45-degree field of view.
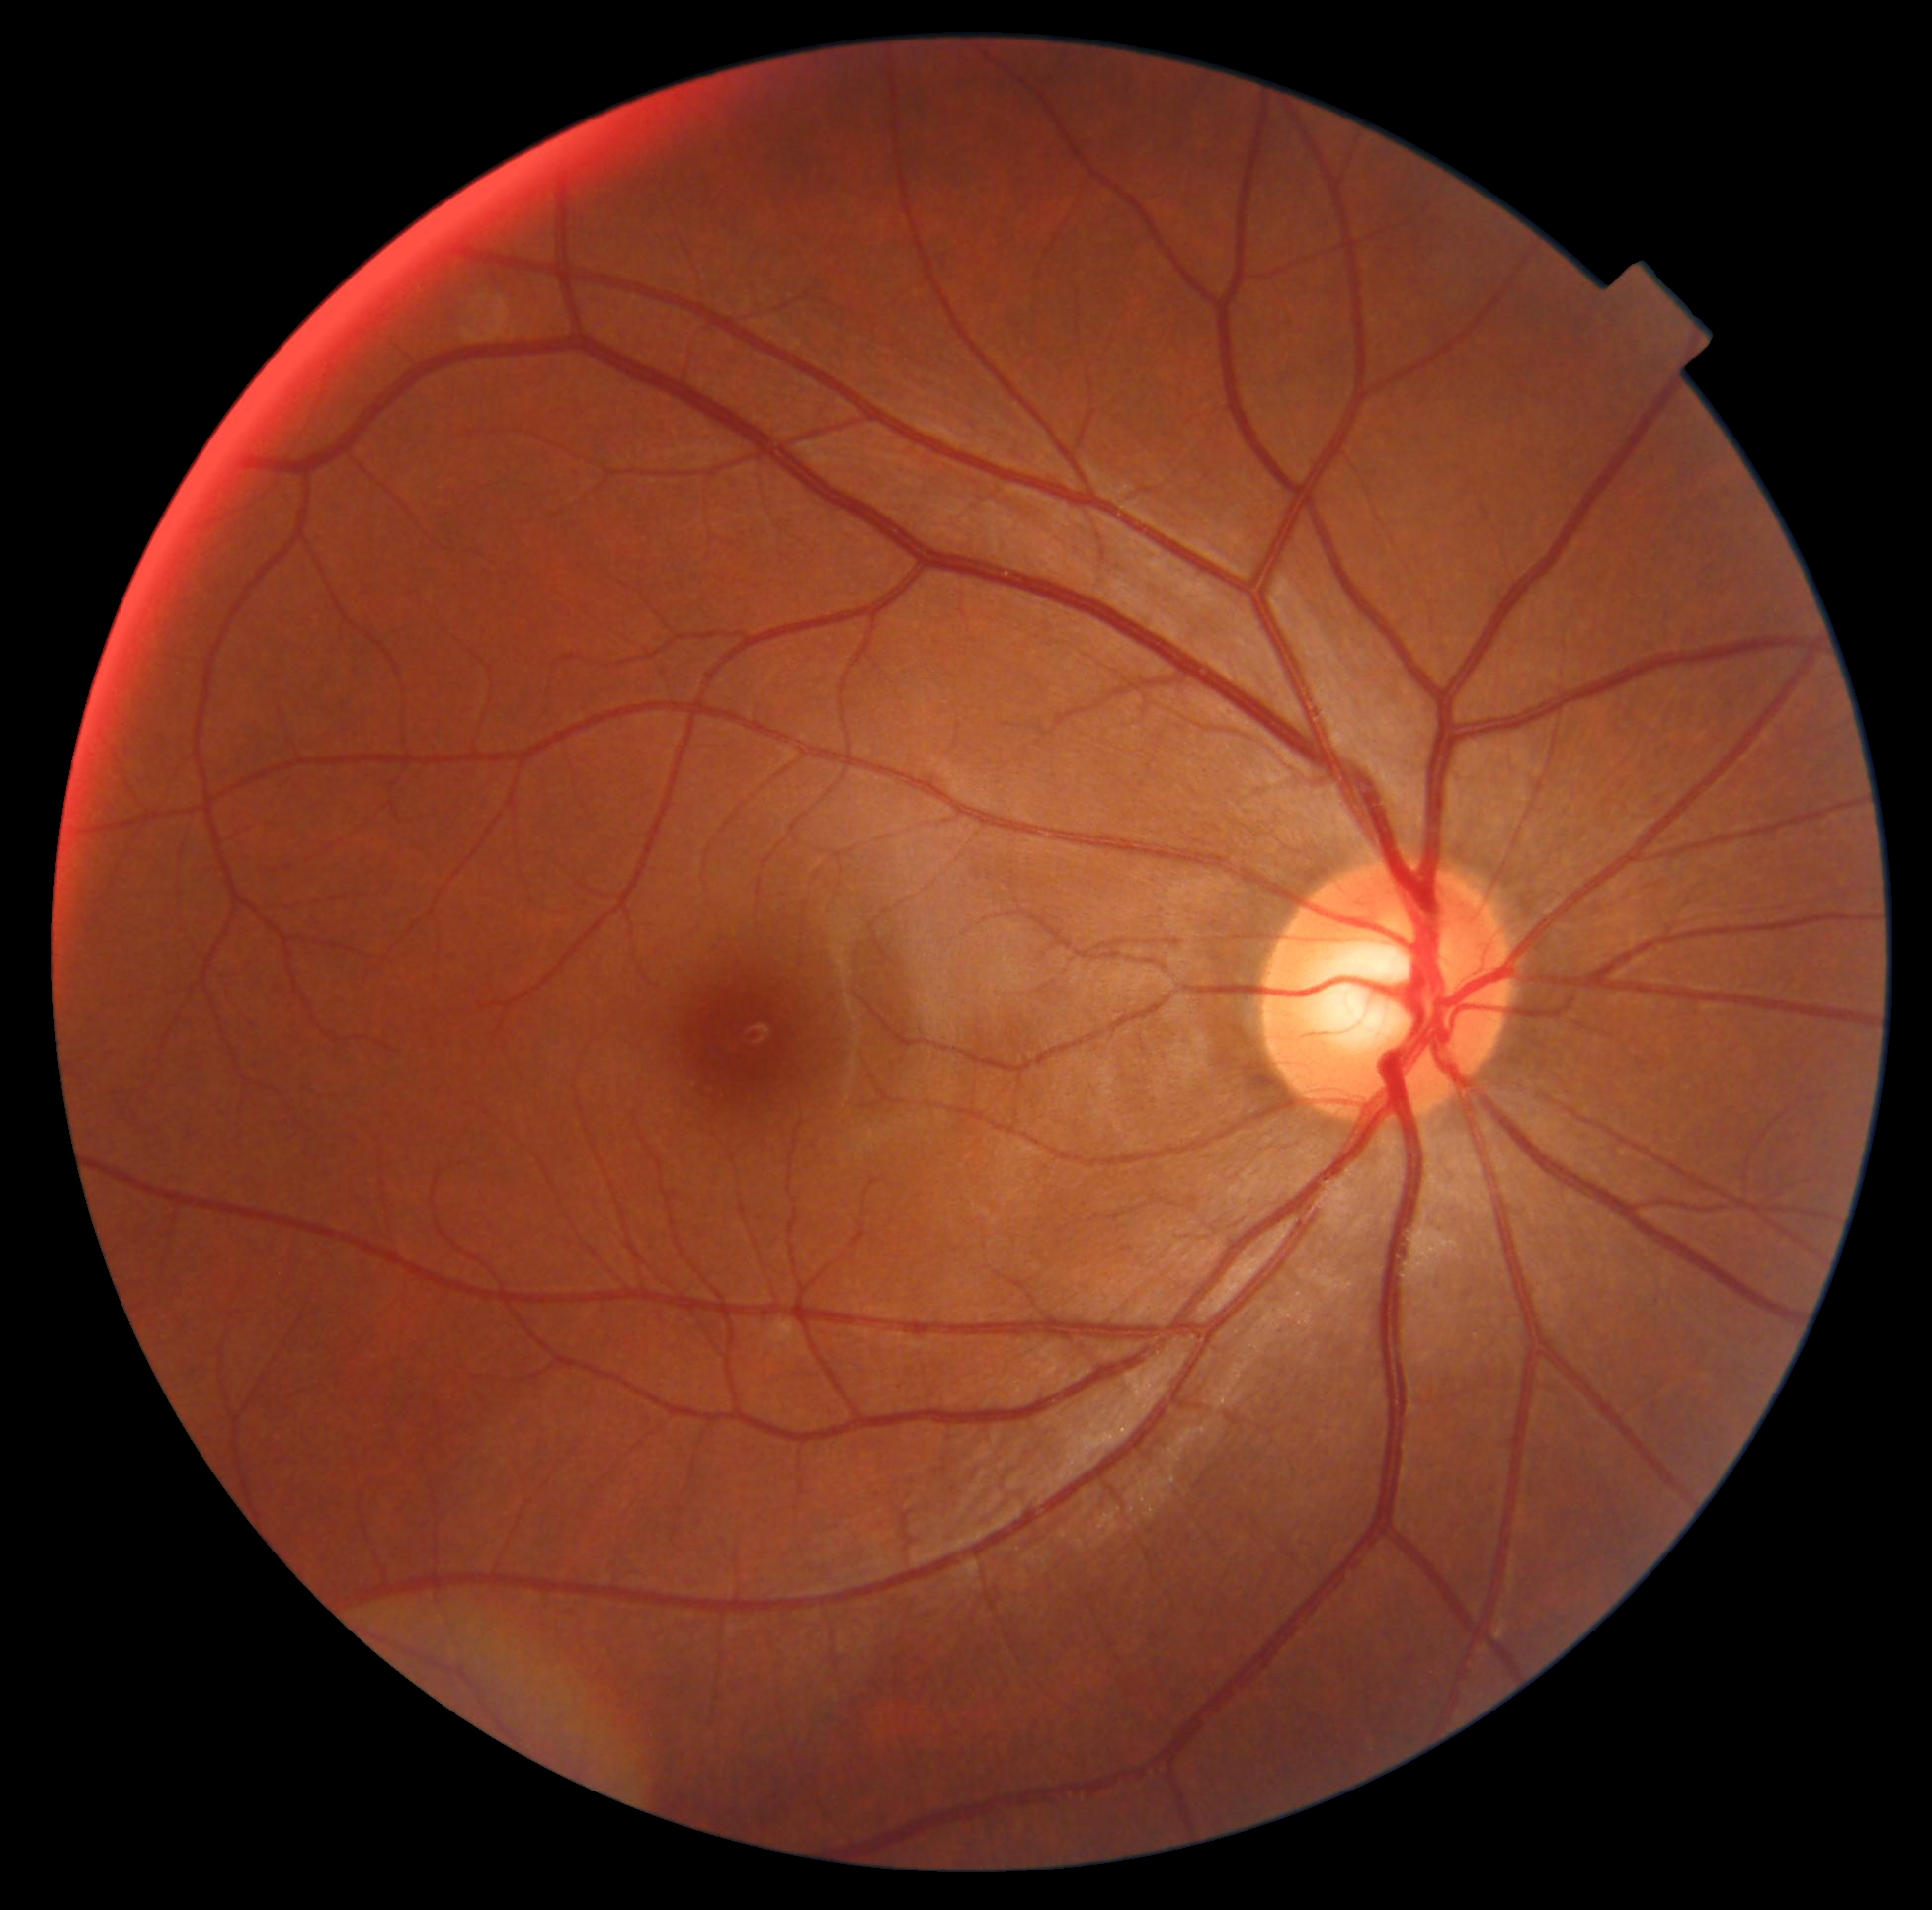 – diabetic retinopathy (DR): no apparent diabetic retinopathy (grade 0) — no visible signs of diabetic retinopathy